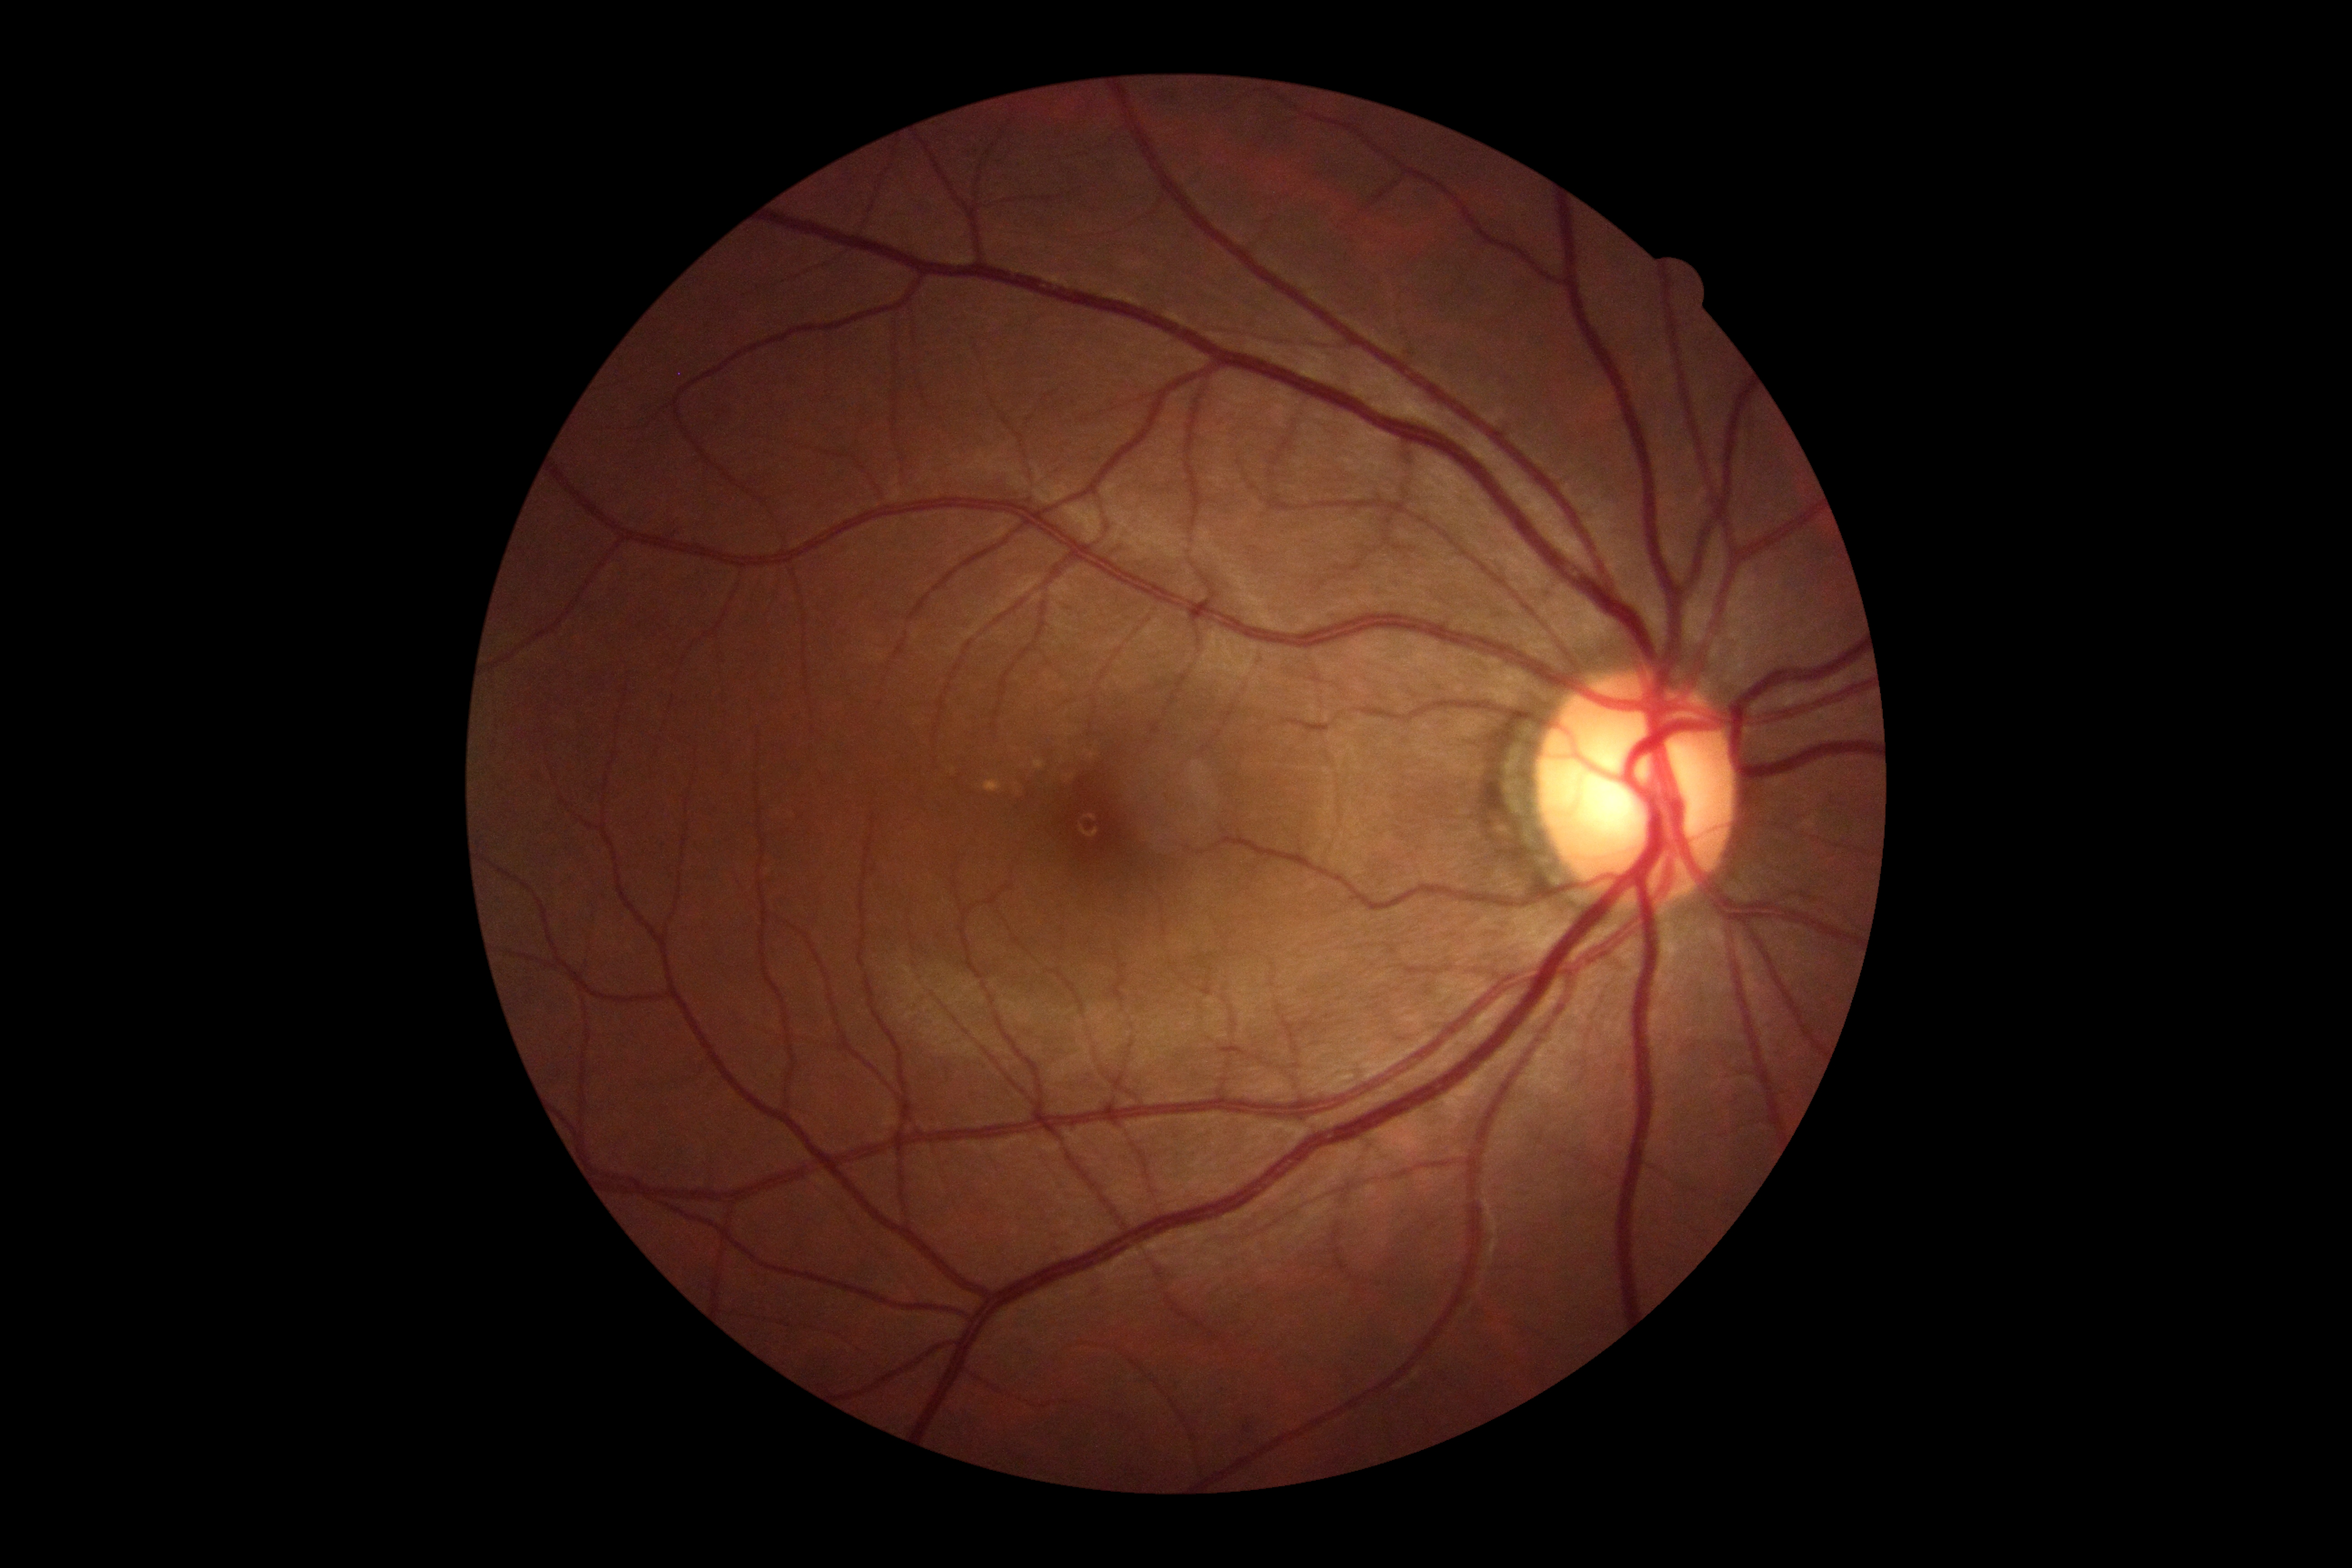 Annotations:
– diabetic retinopathy (DR): grade 0 (no apparent retinopathy)
– DR impression: no apparent DR